1932 x 1910 pixels · 45° field of view · CFP
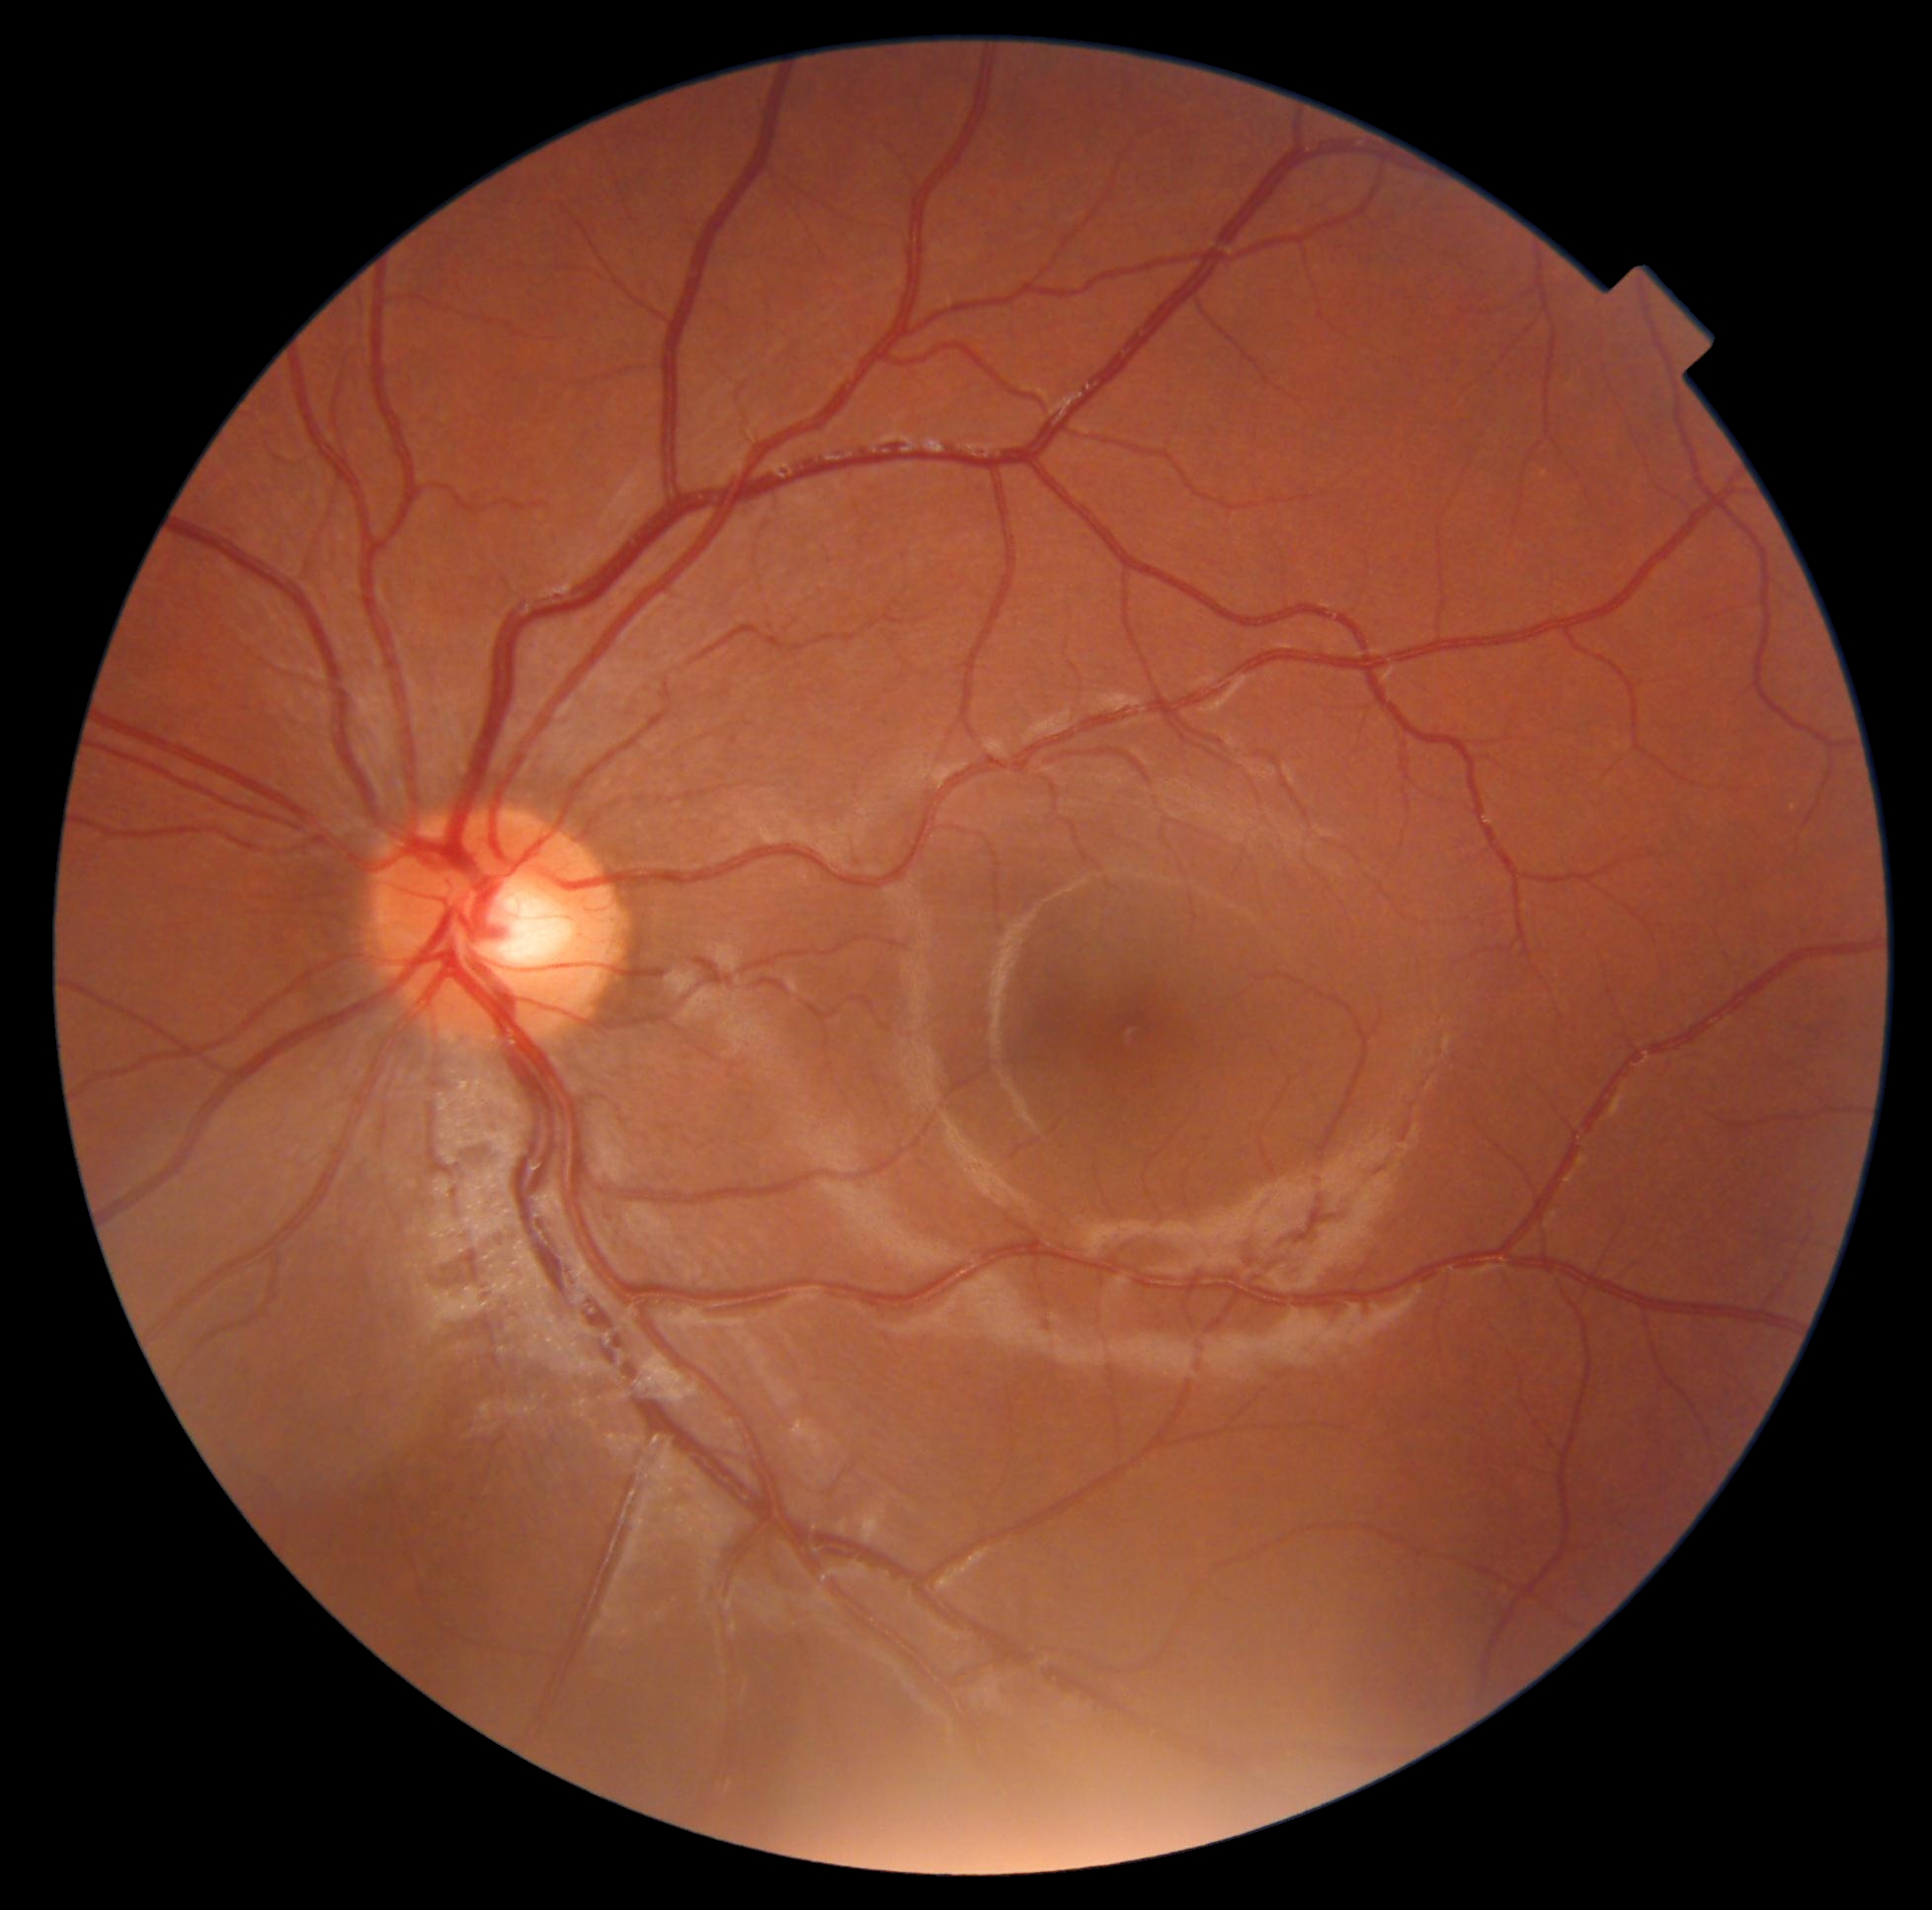
Retinopathy: grade 0 (no apparent retinopathy).